640 x 480 pixels. Captured with the Clarity RetCam 3 (130° field of view). Wide-field contact fundus photograph of an infant — 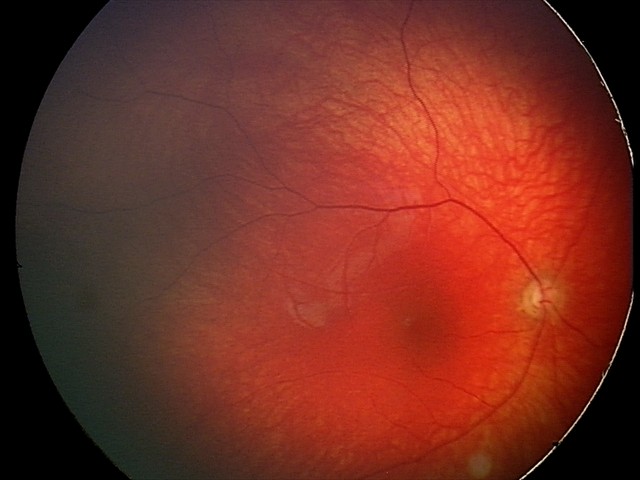 Diagnosis from this screening exam: optic nerve hypoplasia.